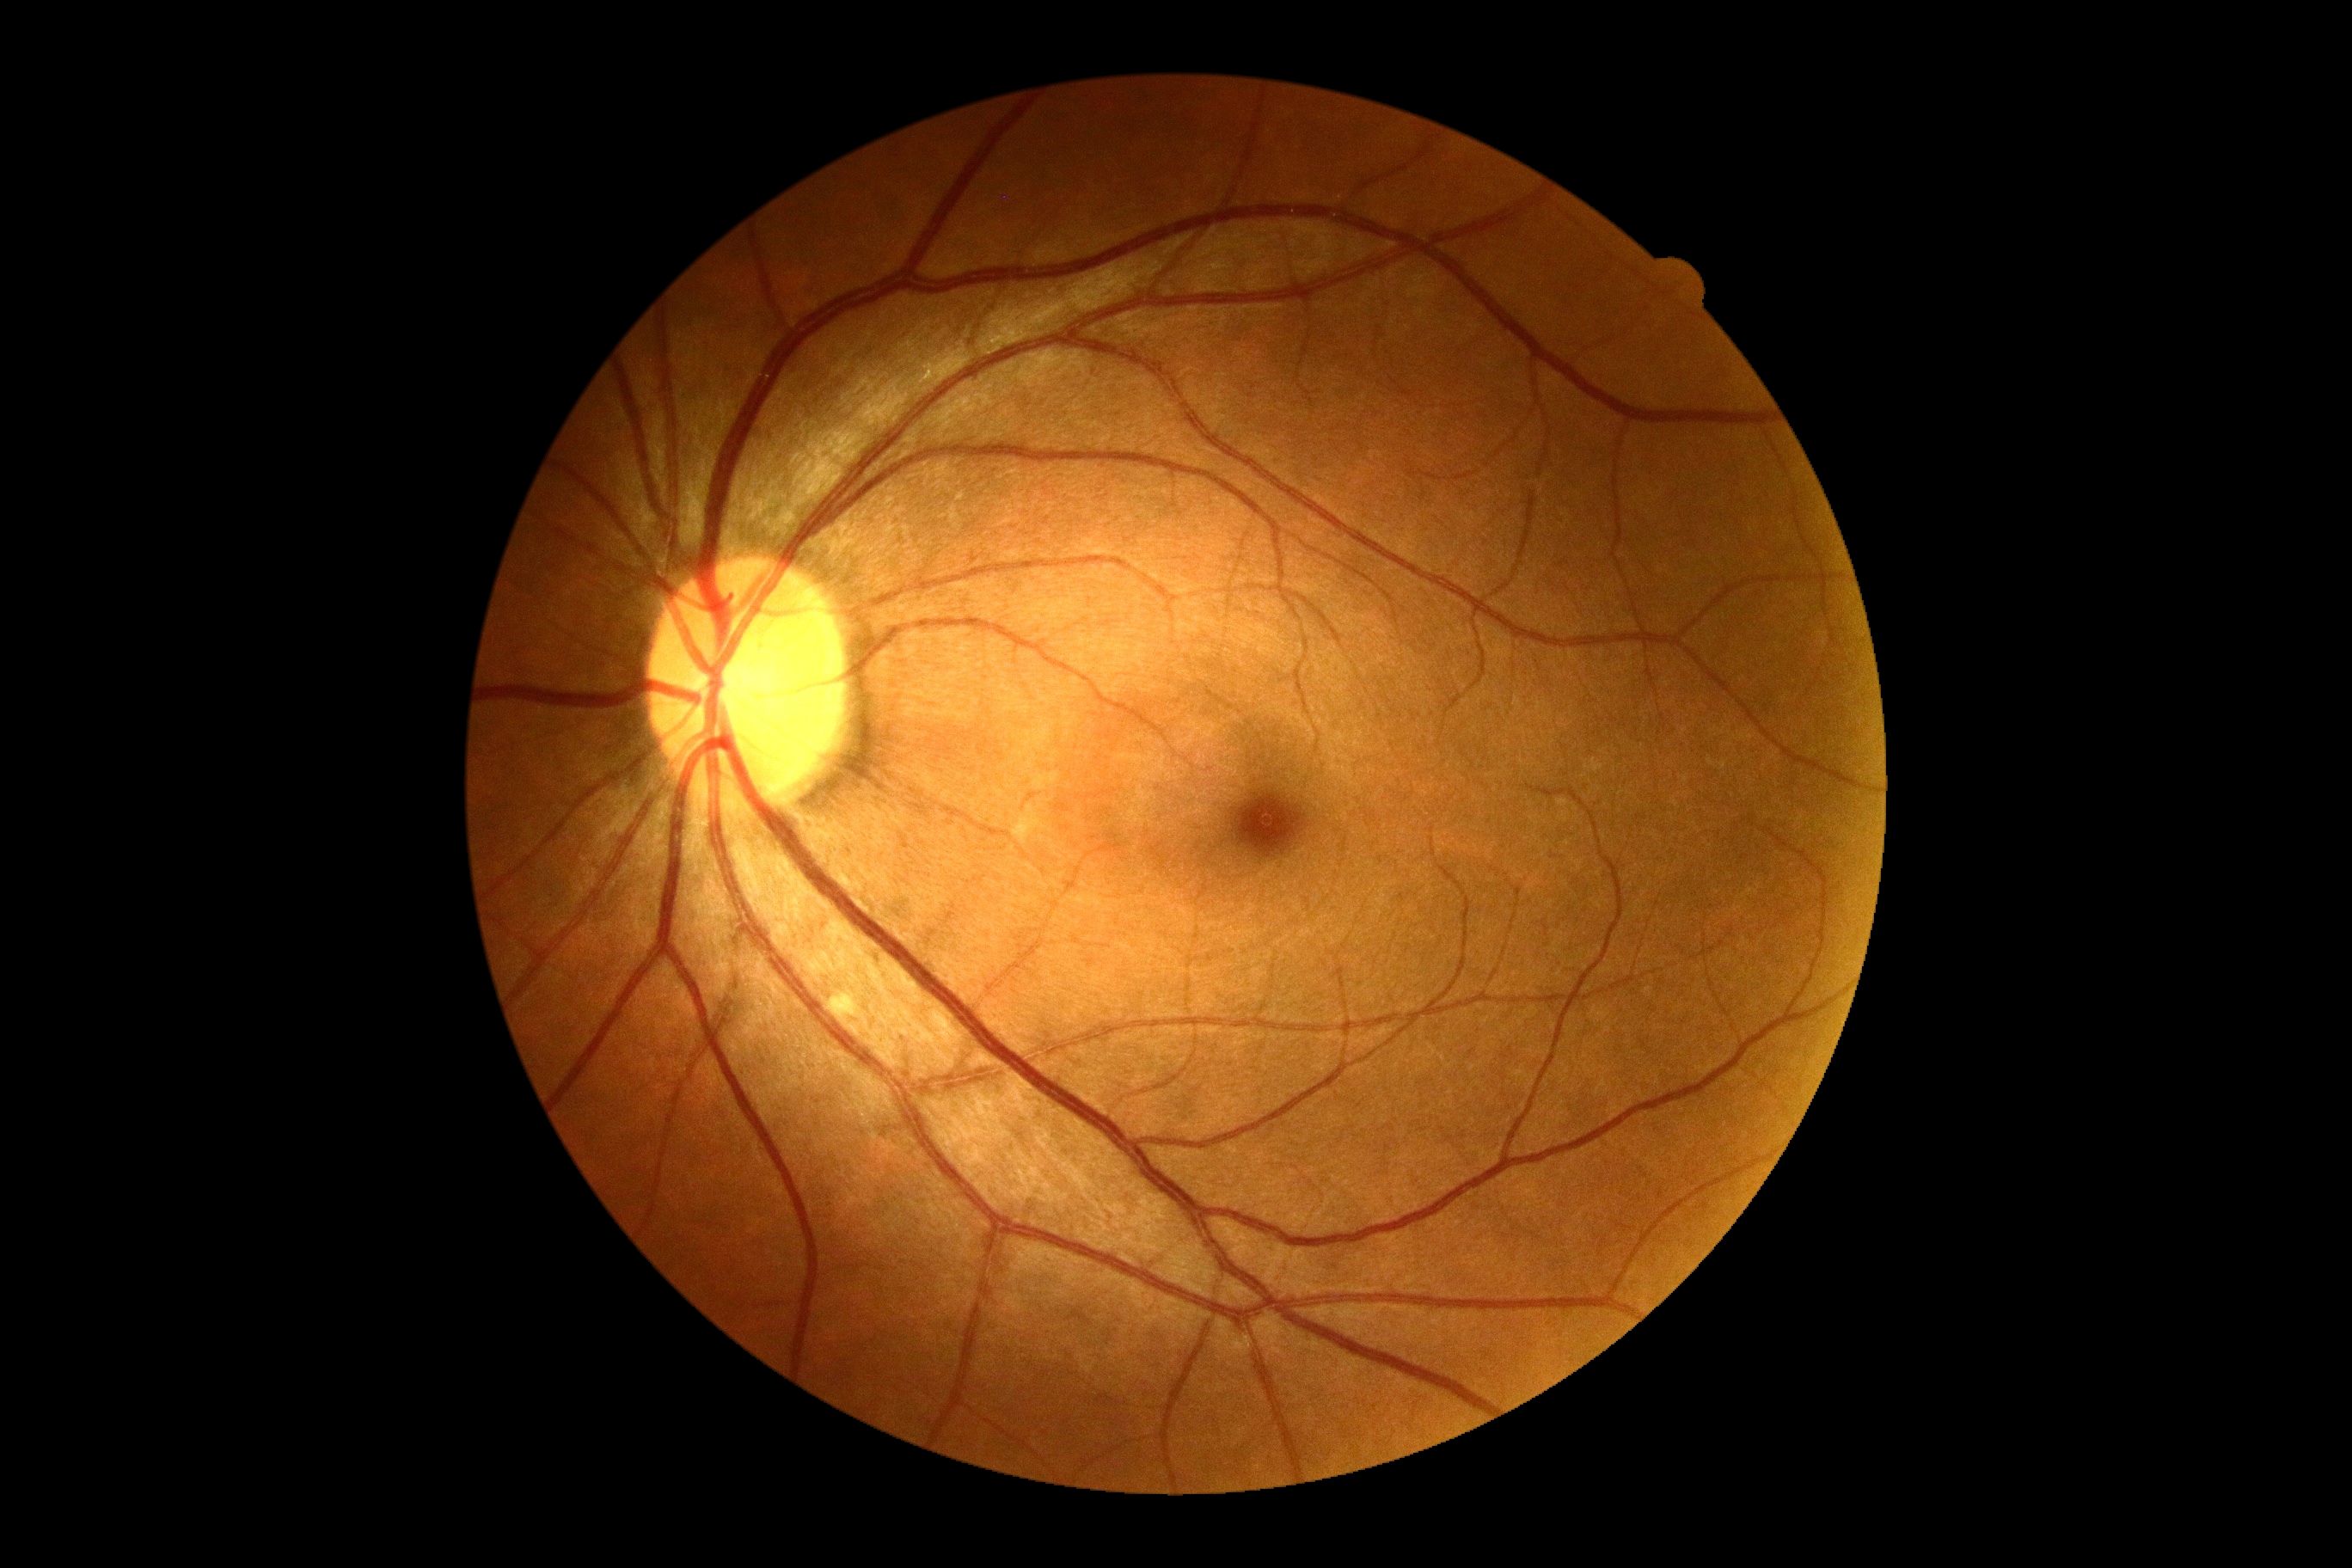
dr_grade: 2
lesions:
  ex: []
  se:
    - <bbox>835, 993, 854, 1017</bbox>
  he: []
  ma: []